Camera: Topcon TRC-NW8; 1932x1932px; dilated-pupil acquisition
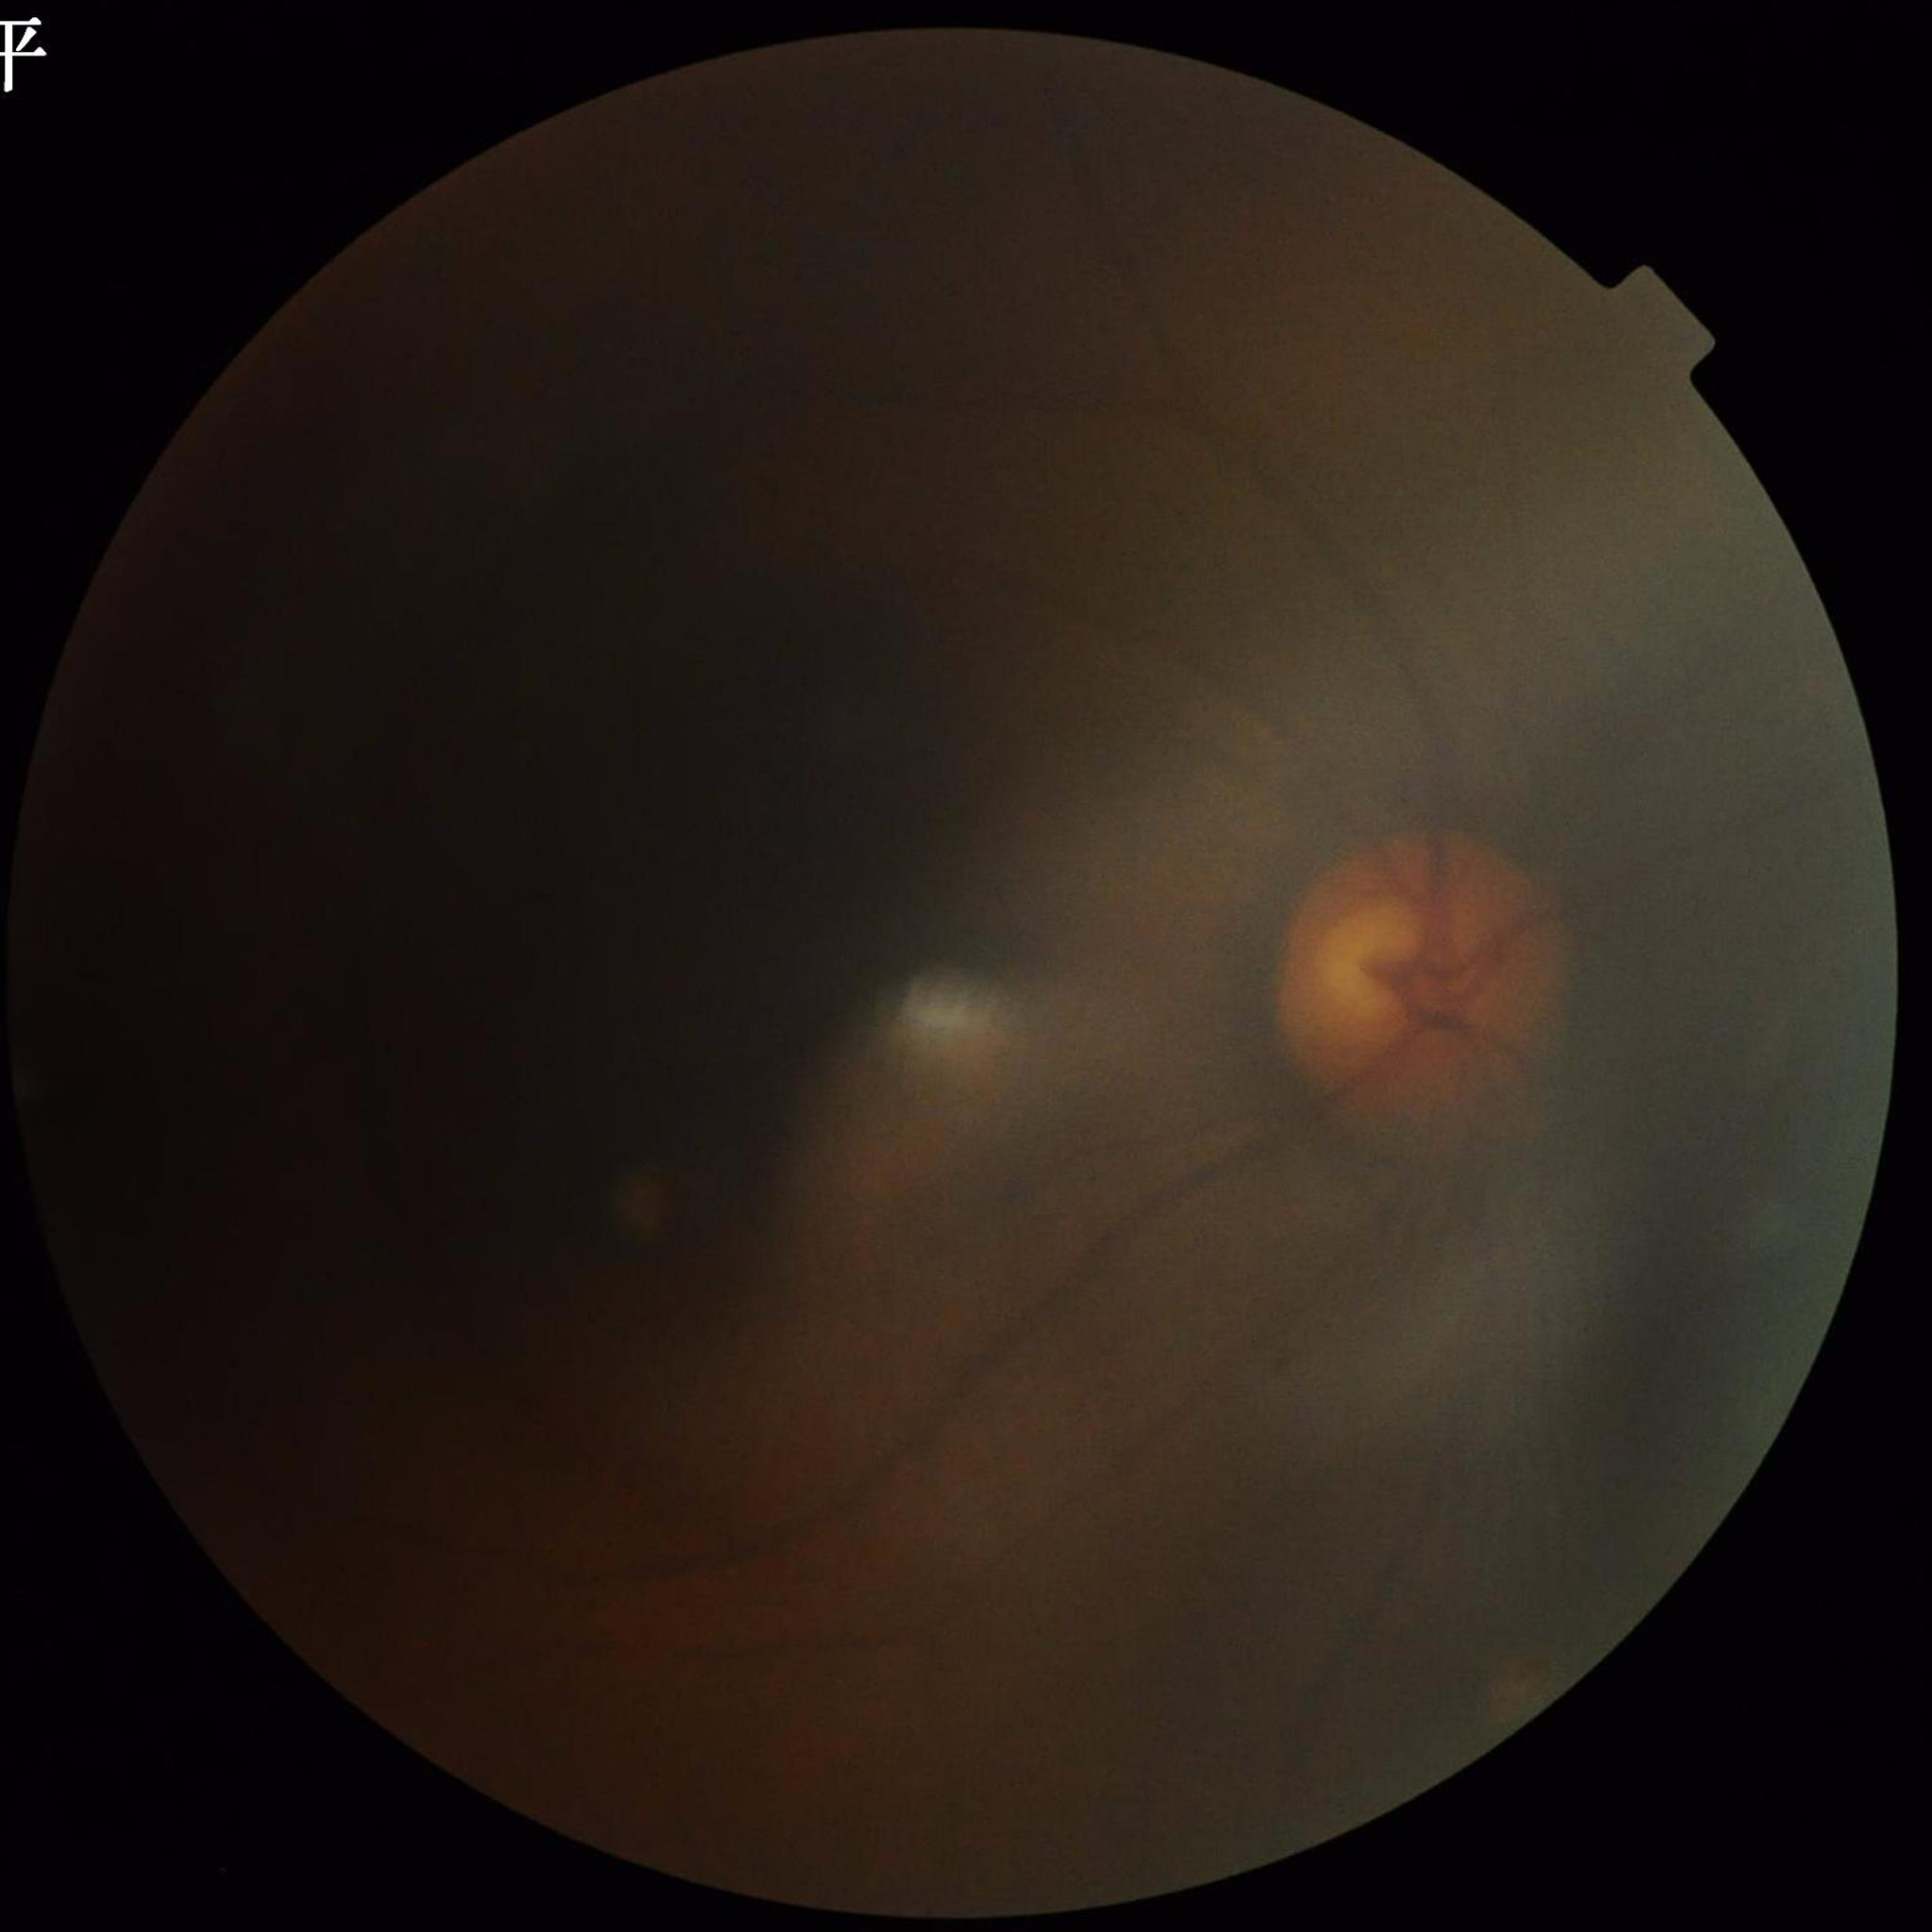

Condition: glaucoma; Quality: blur present, low contrast, illumination/color distortion present.